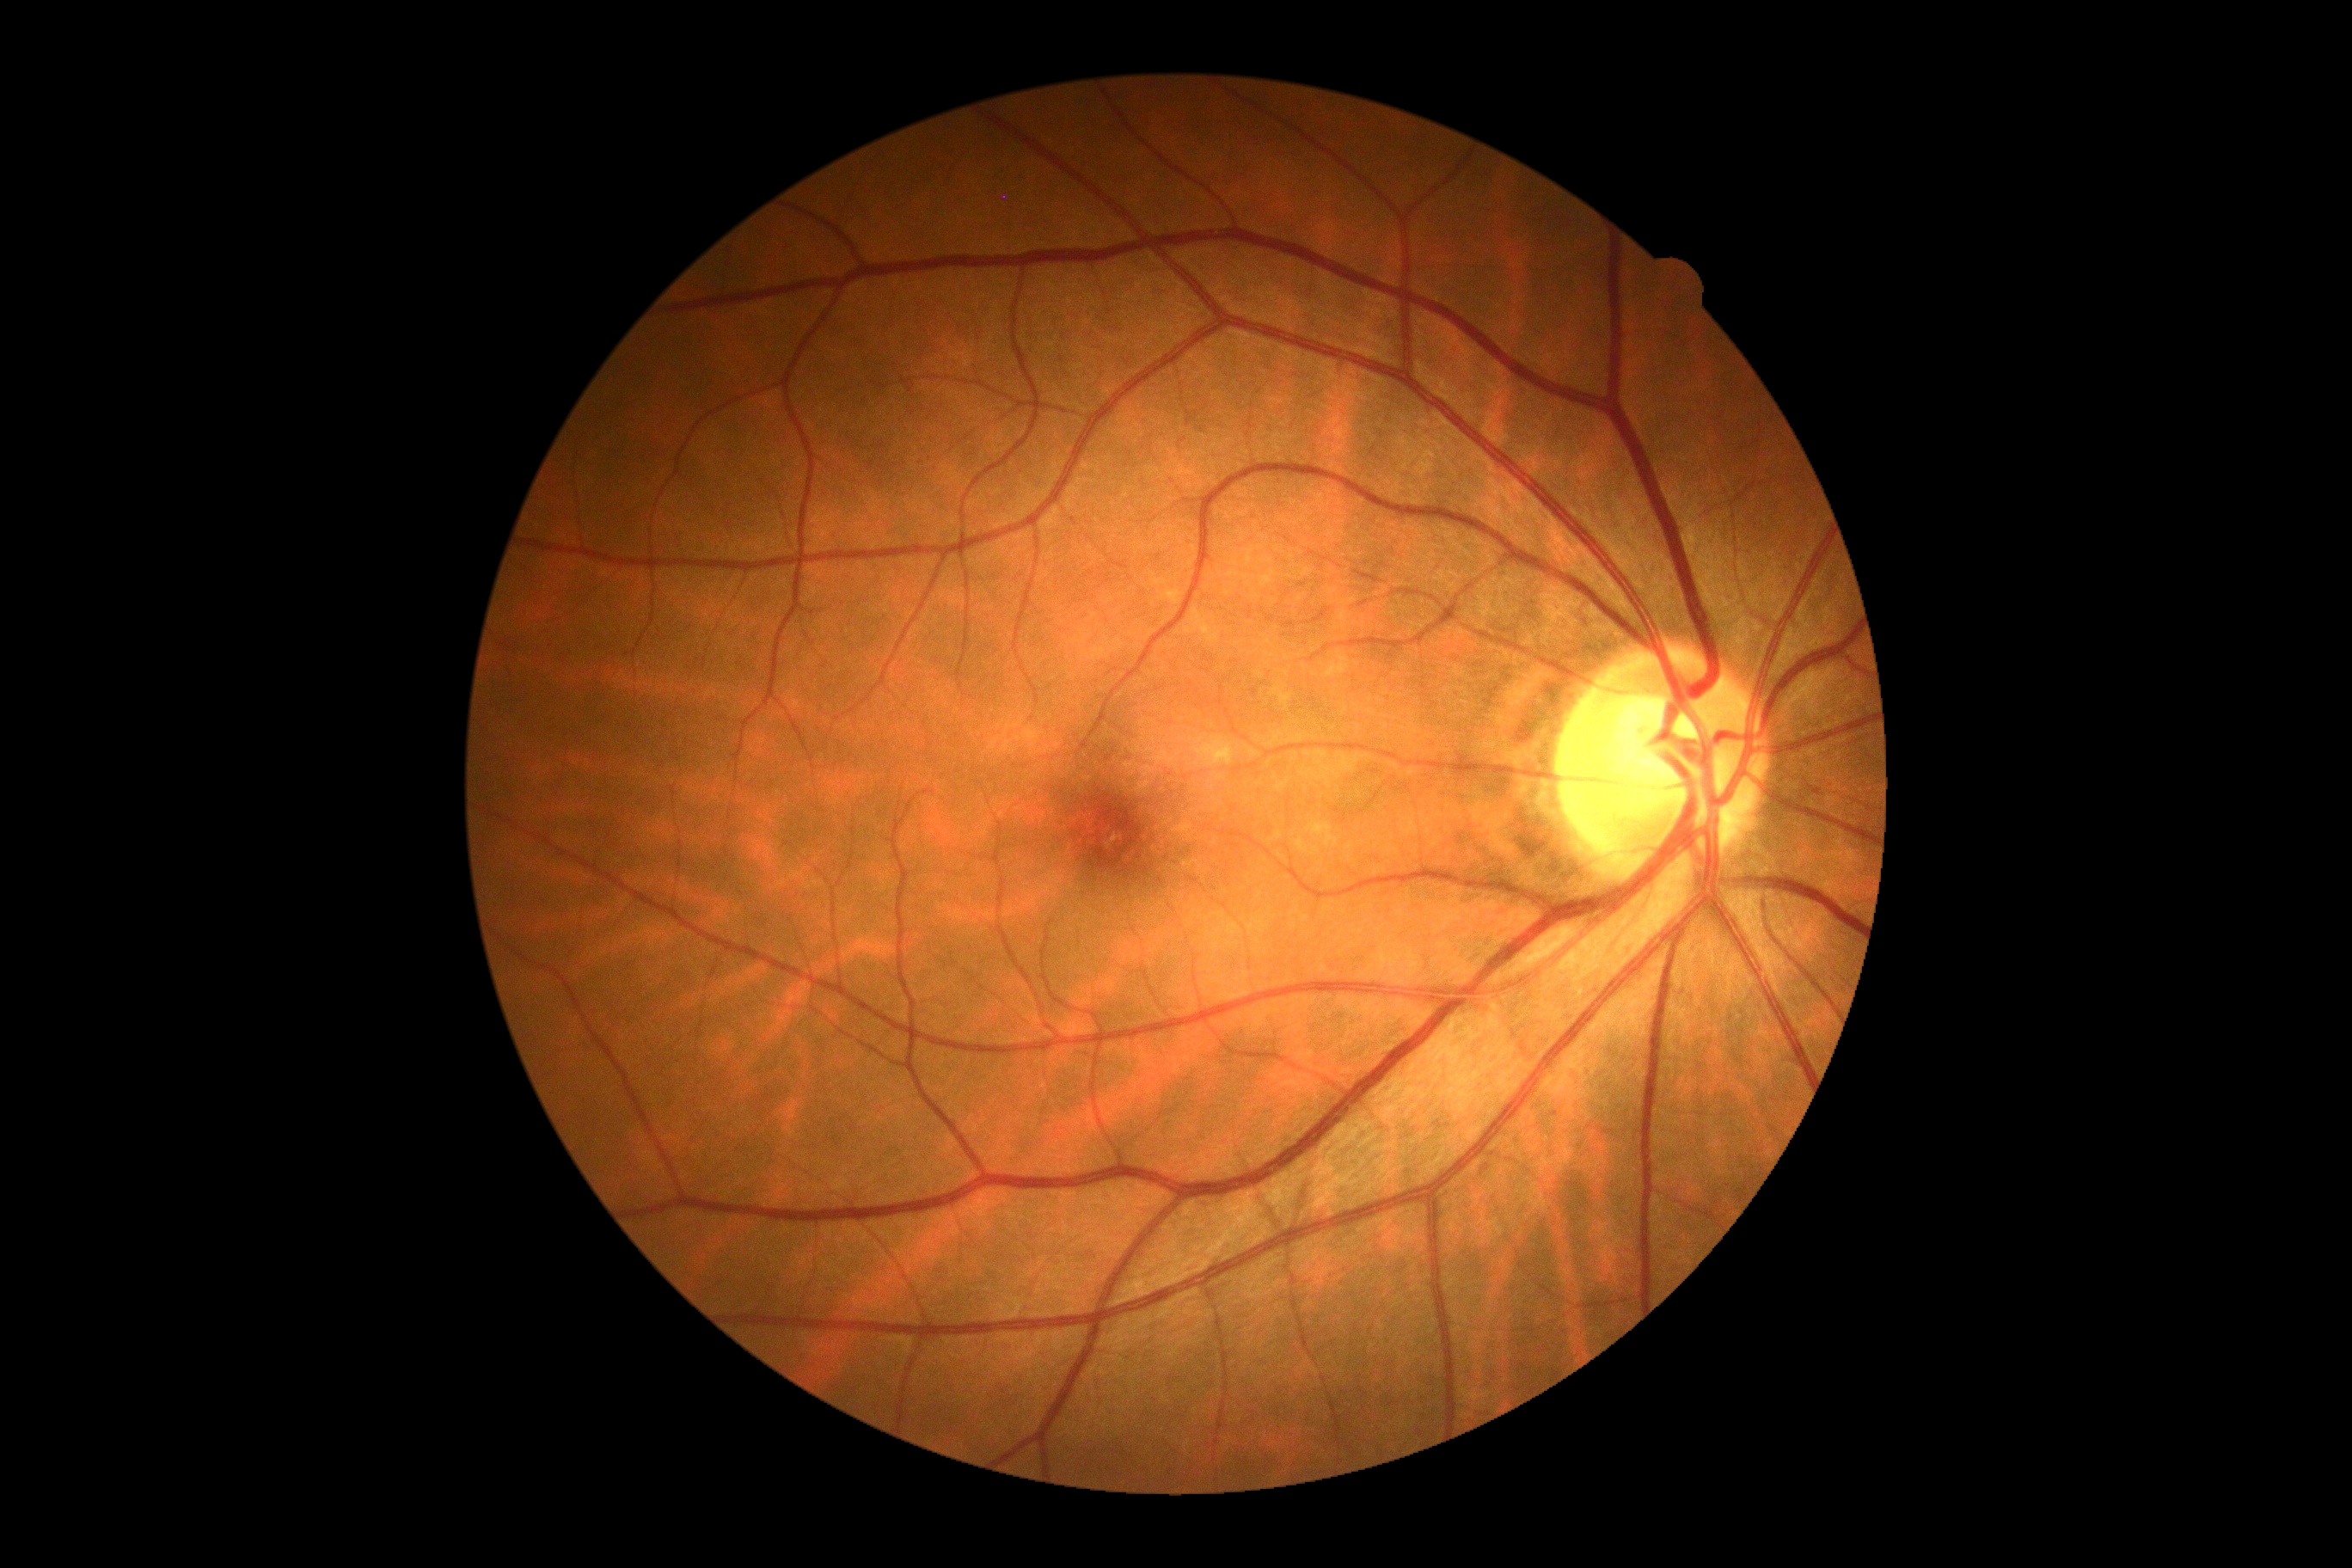
DR stage: grade 0 — no visible signs of diabetic retinopathy